640x480; wide-field contact fundus photograph of an infant: 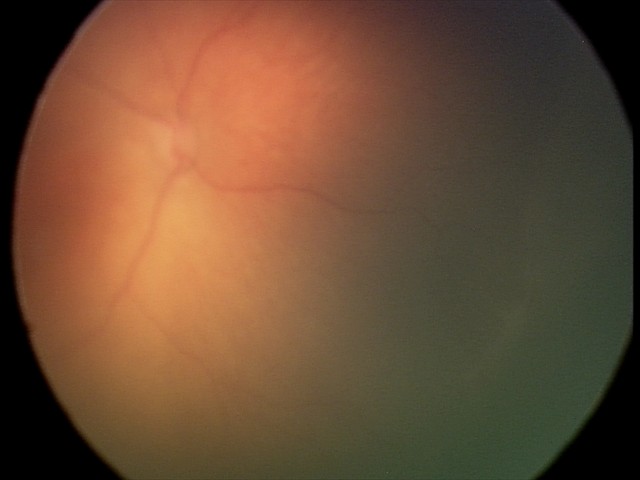

Screening series with ROP stage 1. No plus disease.